DR severity per modified Davis staging. Retinal fundus photograph. 848 x 848 pixels. NIDEK AFC-230 fundus camera. Nonmydriatic fundus photograph. FOV: 45 degrees:
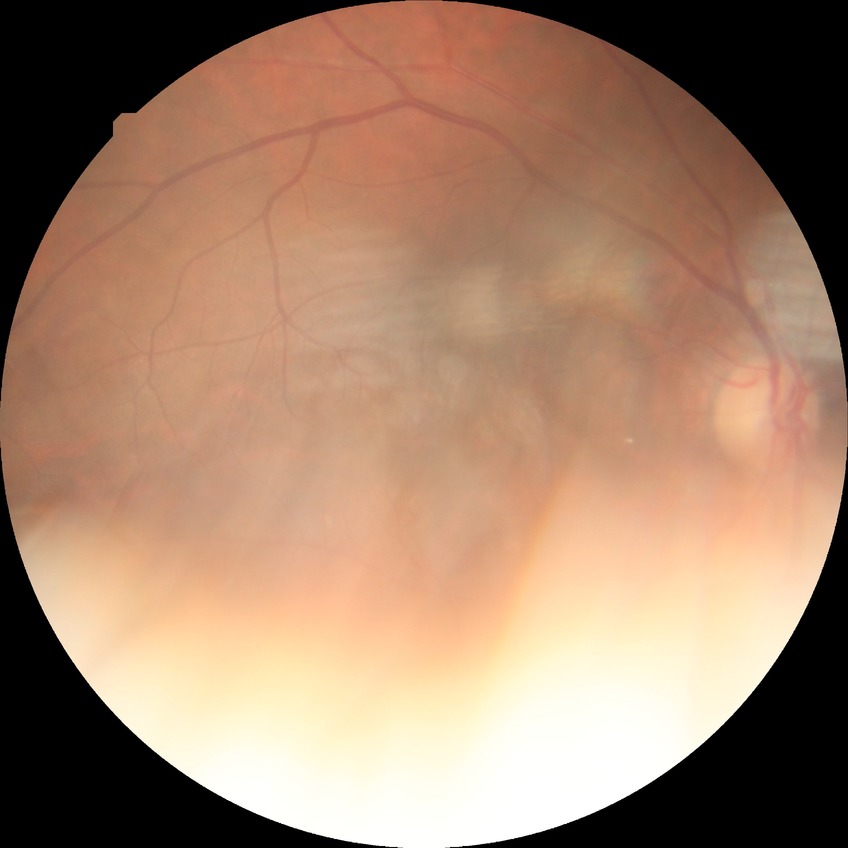
Diabetic retinopathy (DR) is no diabetic retinopathy (NDR).